45-degree field of view. 2212 x 1659 pixels. Color fundus photograph:
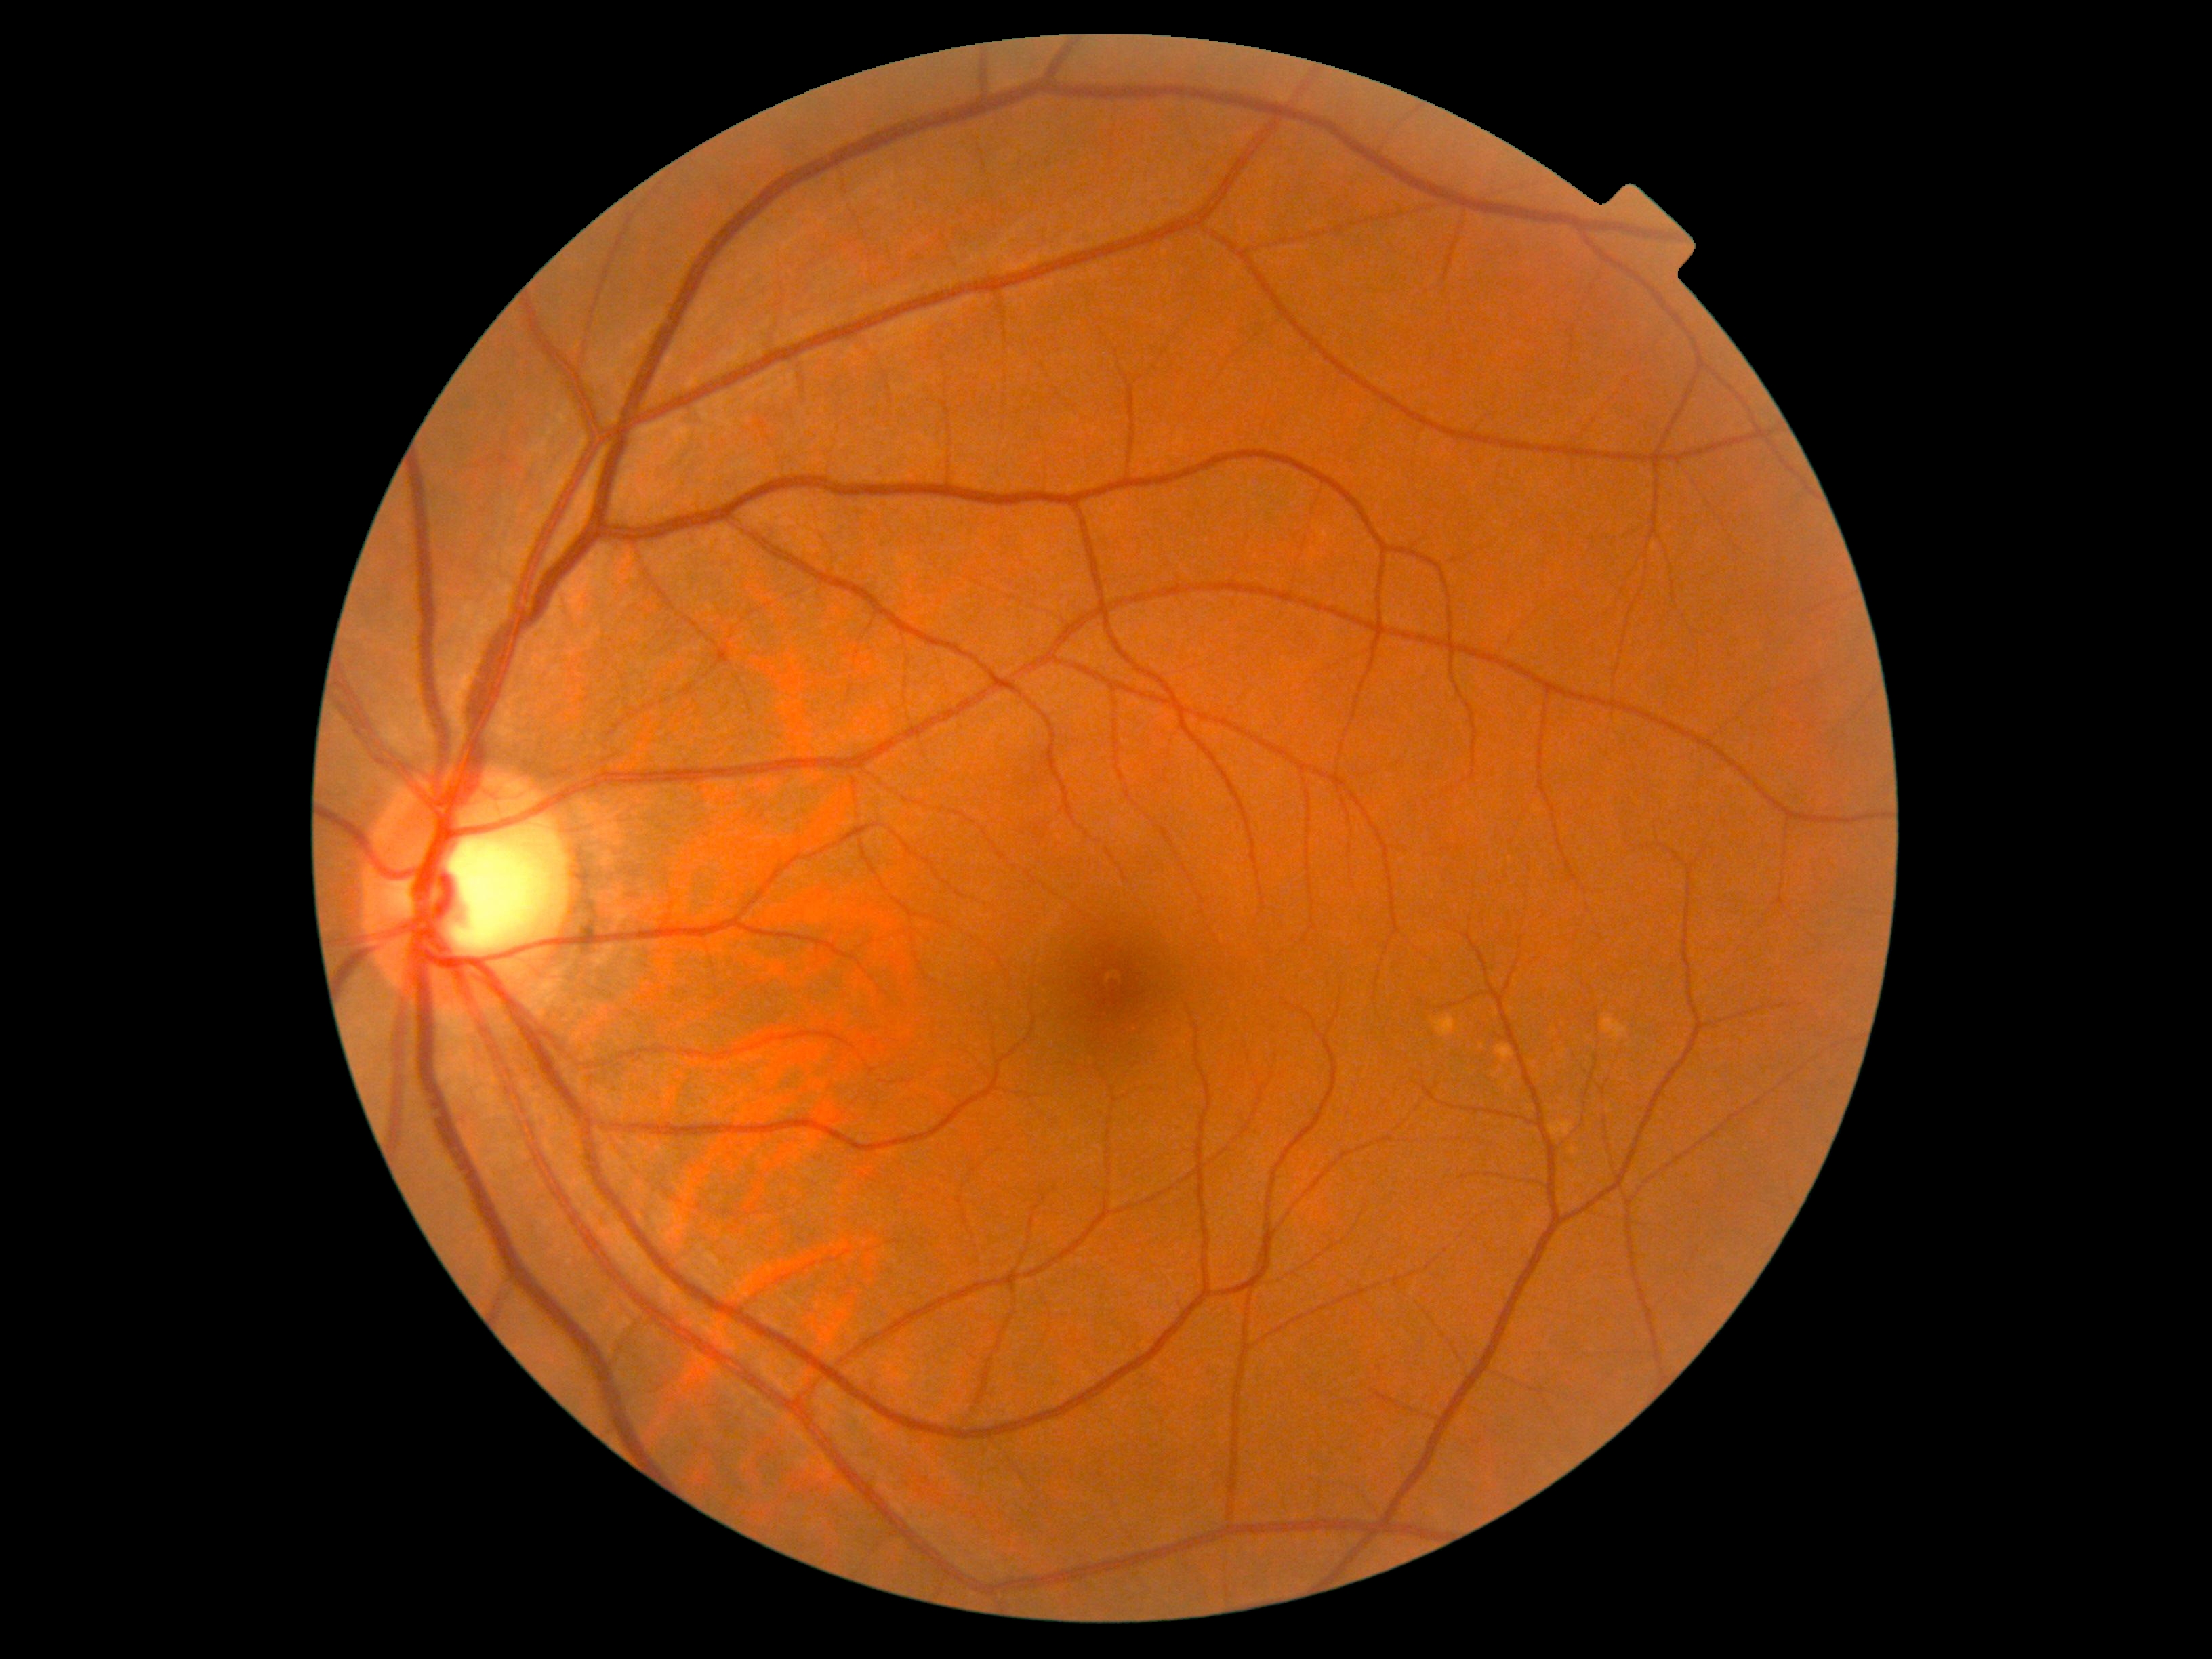 Diabetic retinopathy severity: grade 0.